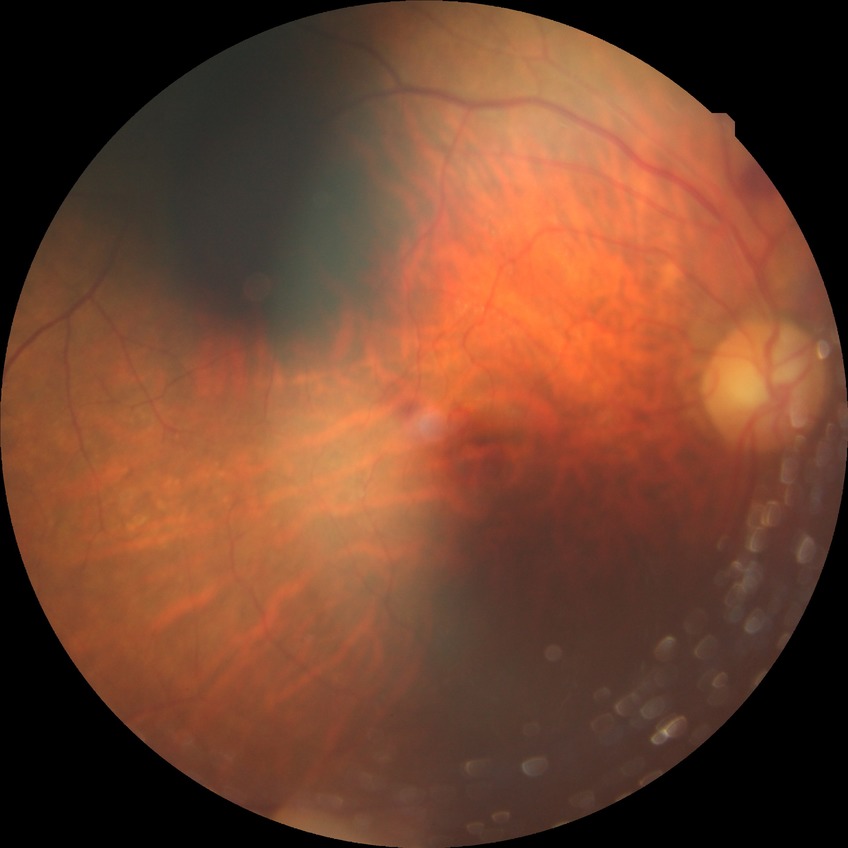

diabetic retinopathy (DR): no diabetic retinopathy (NDR).